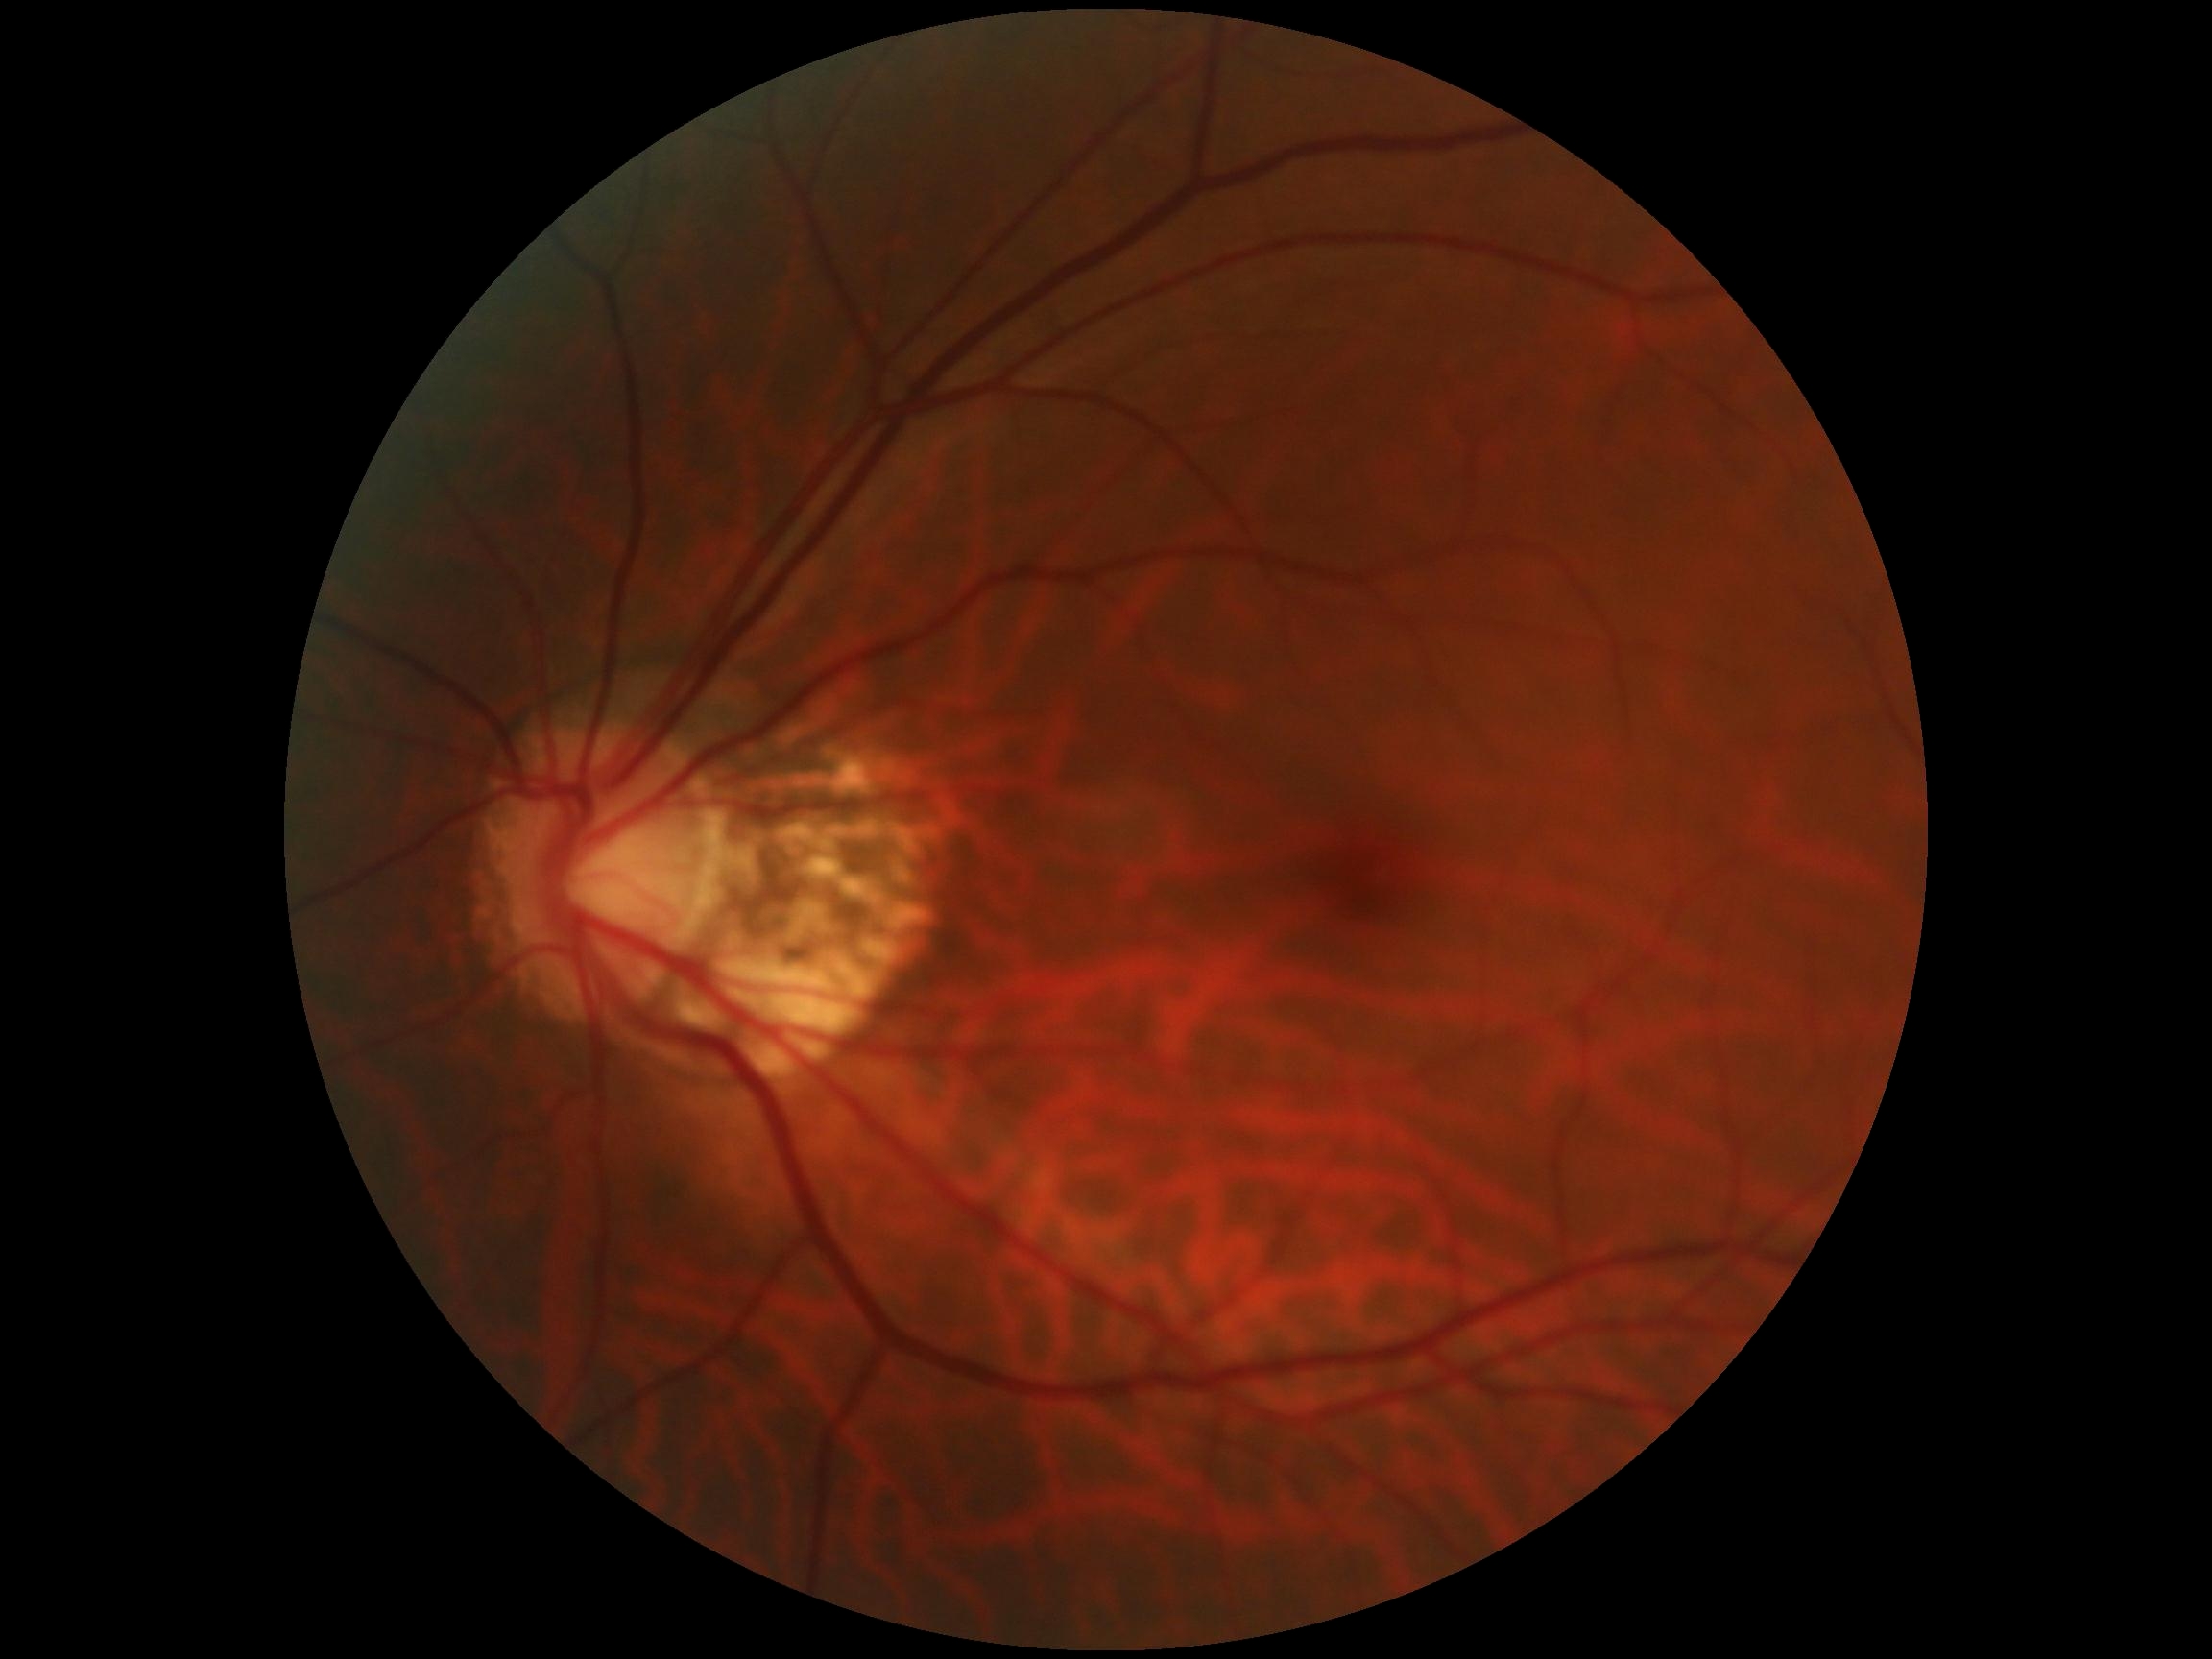 Diabetic retinopathy (DR) is 0/4.